130° field of view (Clarity RetCam 3). Wide-field fundus photograph of an infant: 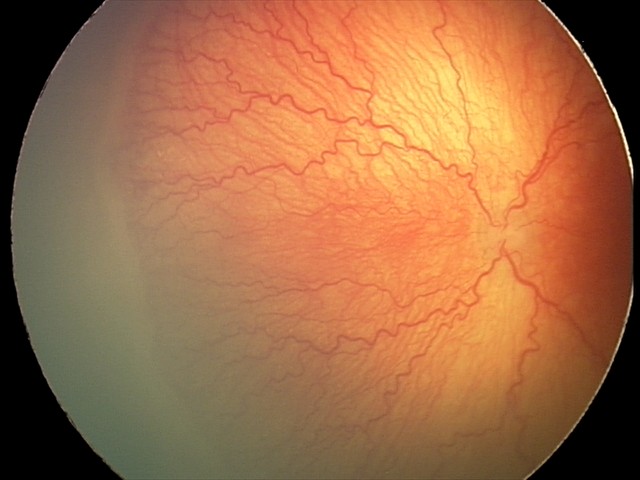 Screening series with A-ROP (aggressive ROP).